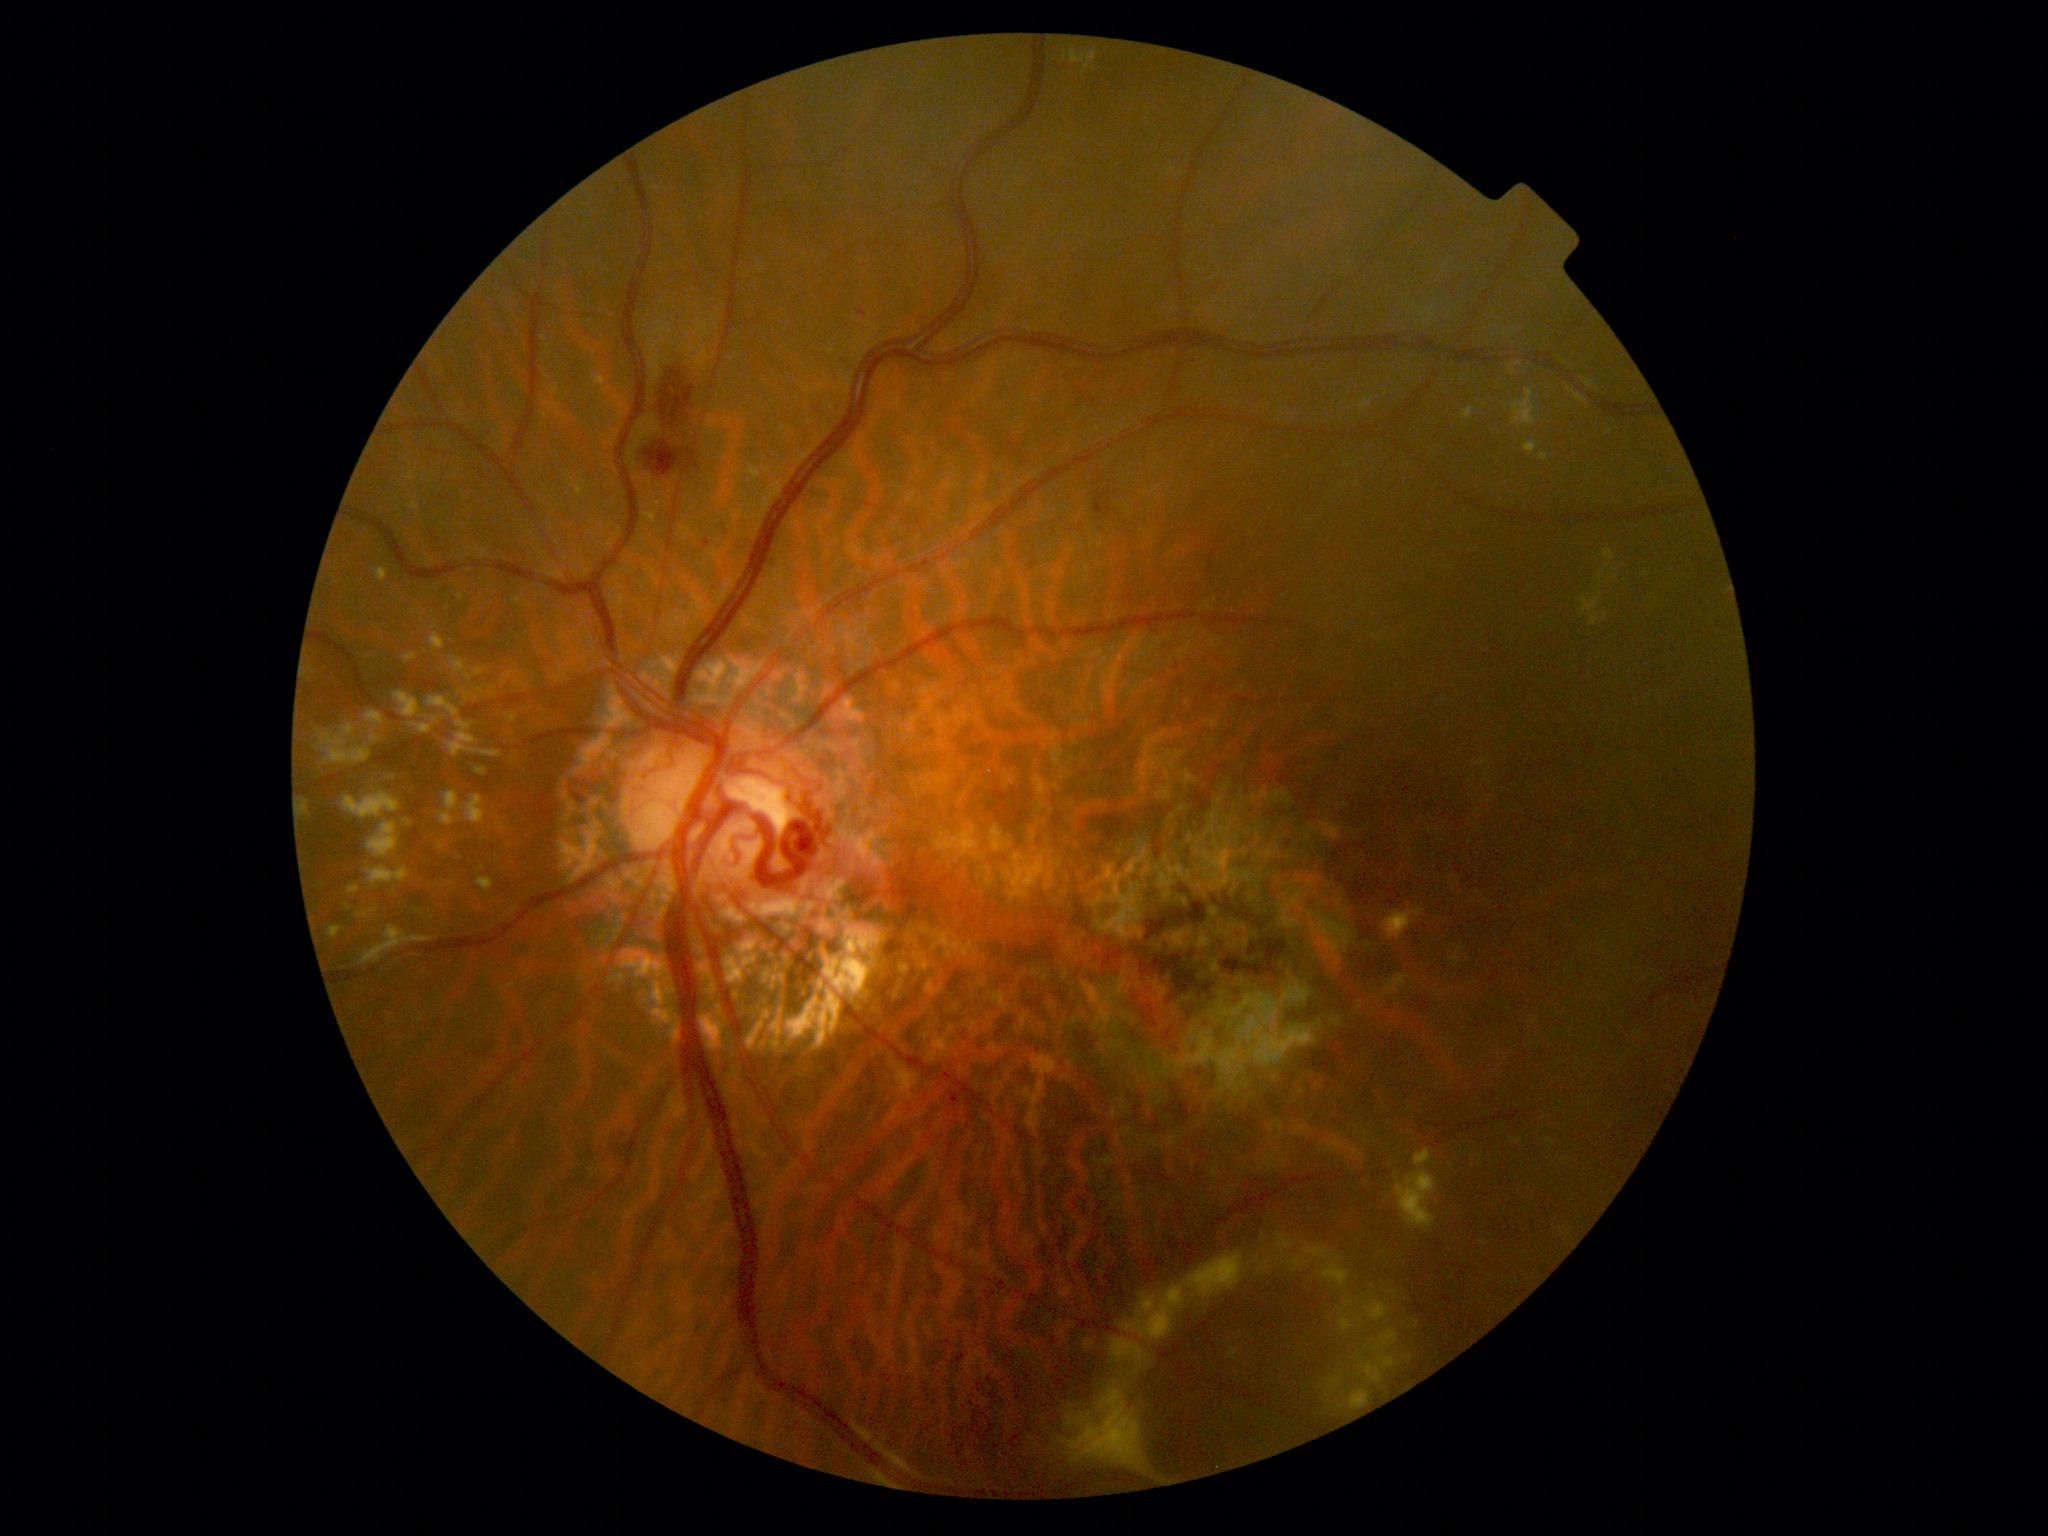
{"partial": true, "dr_grade": 2, "dr_grade_name": "moderate NPDR", "lesions": {"se": null, "ex": [[360, 925, 434, 965], [327, 926, 343, 939], [443, 788, 454, 810], [440, 813, 453, 828], [348, 885, 361, 895], [1331, 1377, 1341, 1385], [1145, 1314, 1169, 1340], [368, 730, 381, 743], [1363, 1363, 1384, 1384], [343, 793, 401, 819], [408, 722, 436, 735], [1143, 1296, 1153, 1307], [1513, 389, 1537, 425], [1407, 1211, 1428, 1230], [1398, 1196, 1423, 1207], [467, 792, 483, 821], [1065, 1386, 1146, 1471], [411, 504, 420, 510]], "he": [[1100, 497, 1106, 506], [659, 354, 695, 428], [643, 431, 678, 471], [702, 534, 709, 550]], "ma": null}}